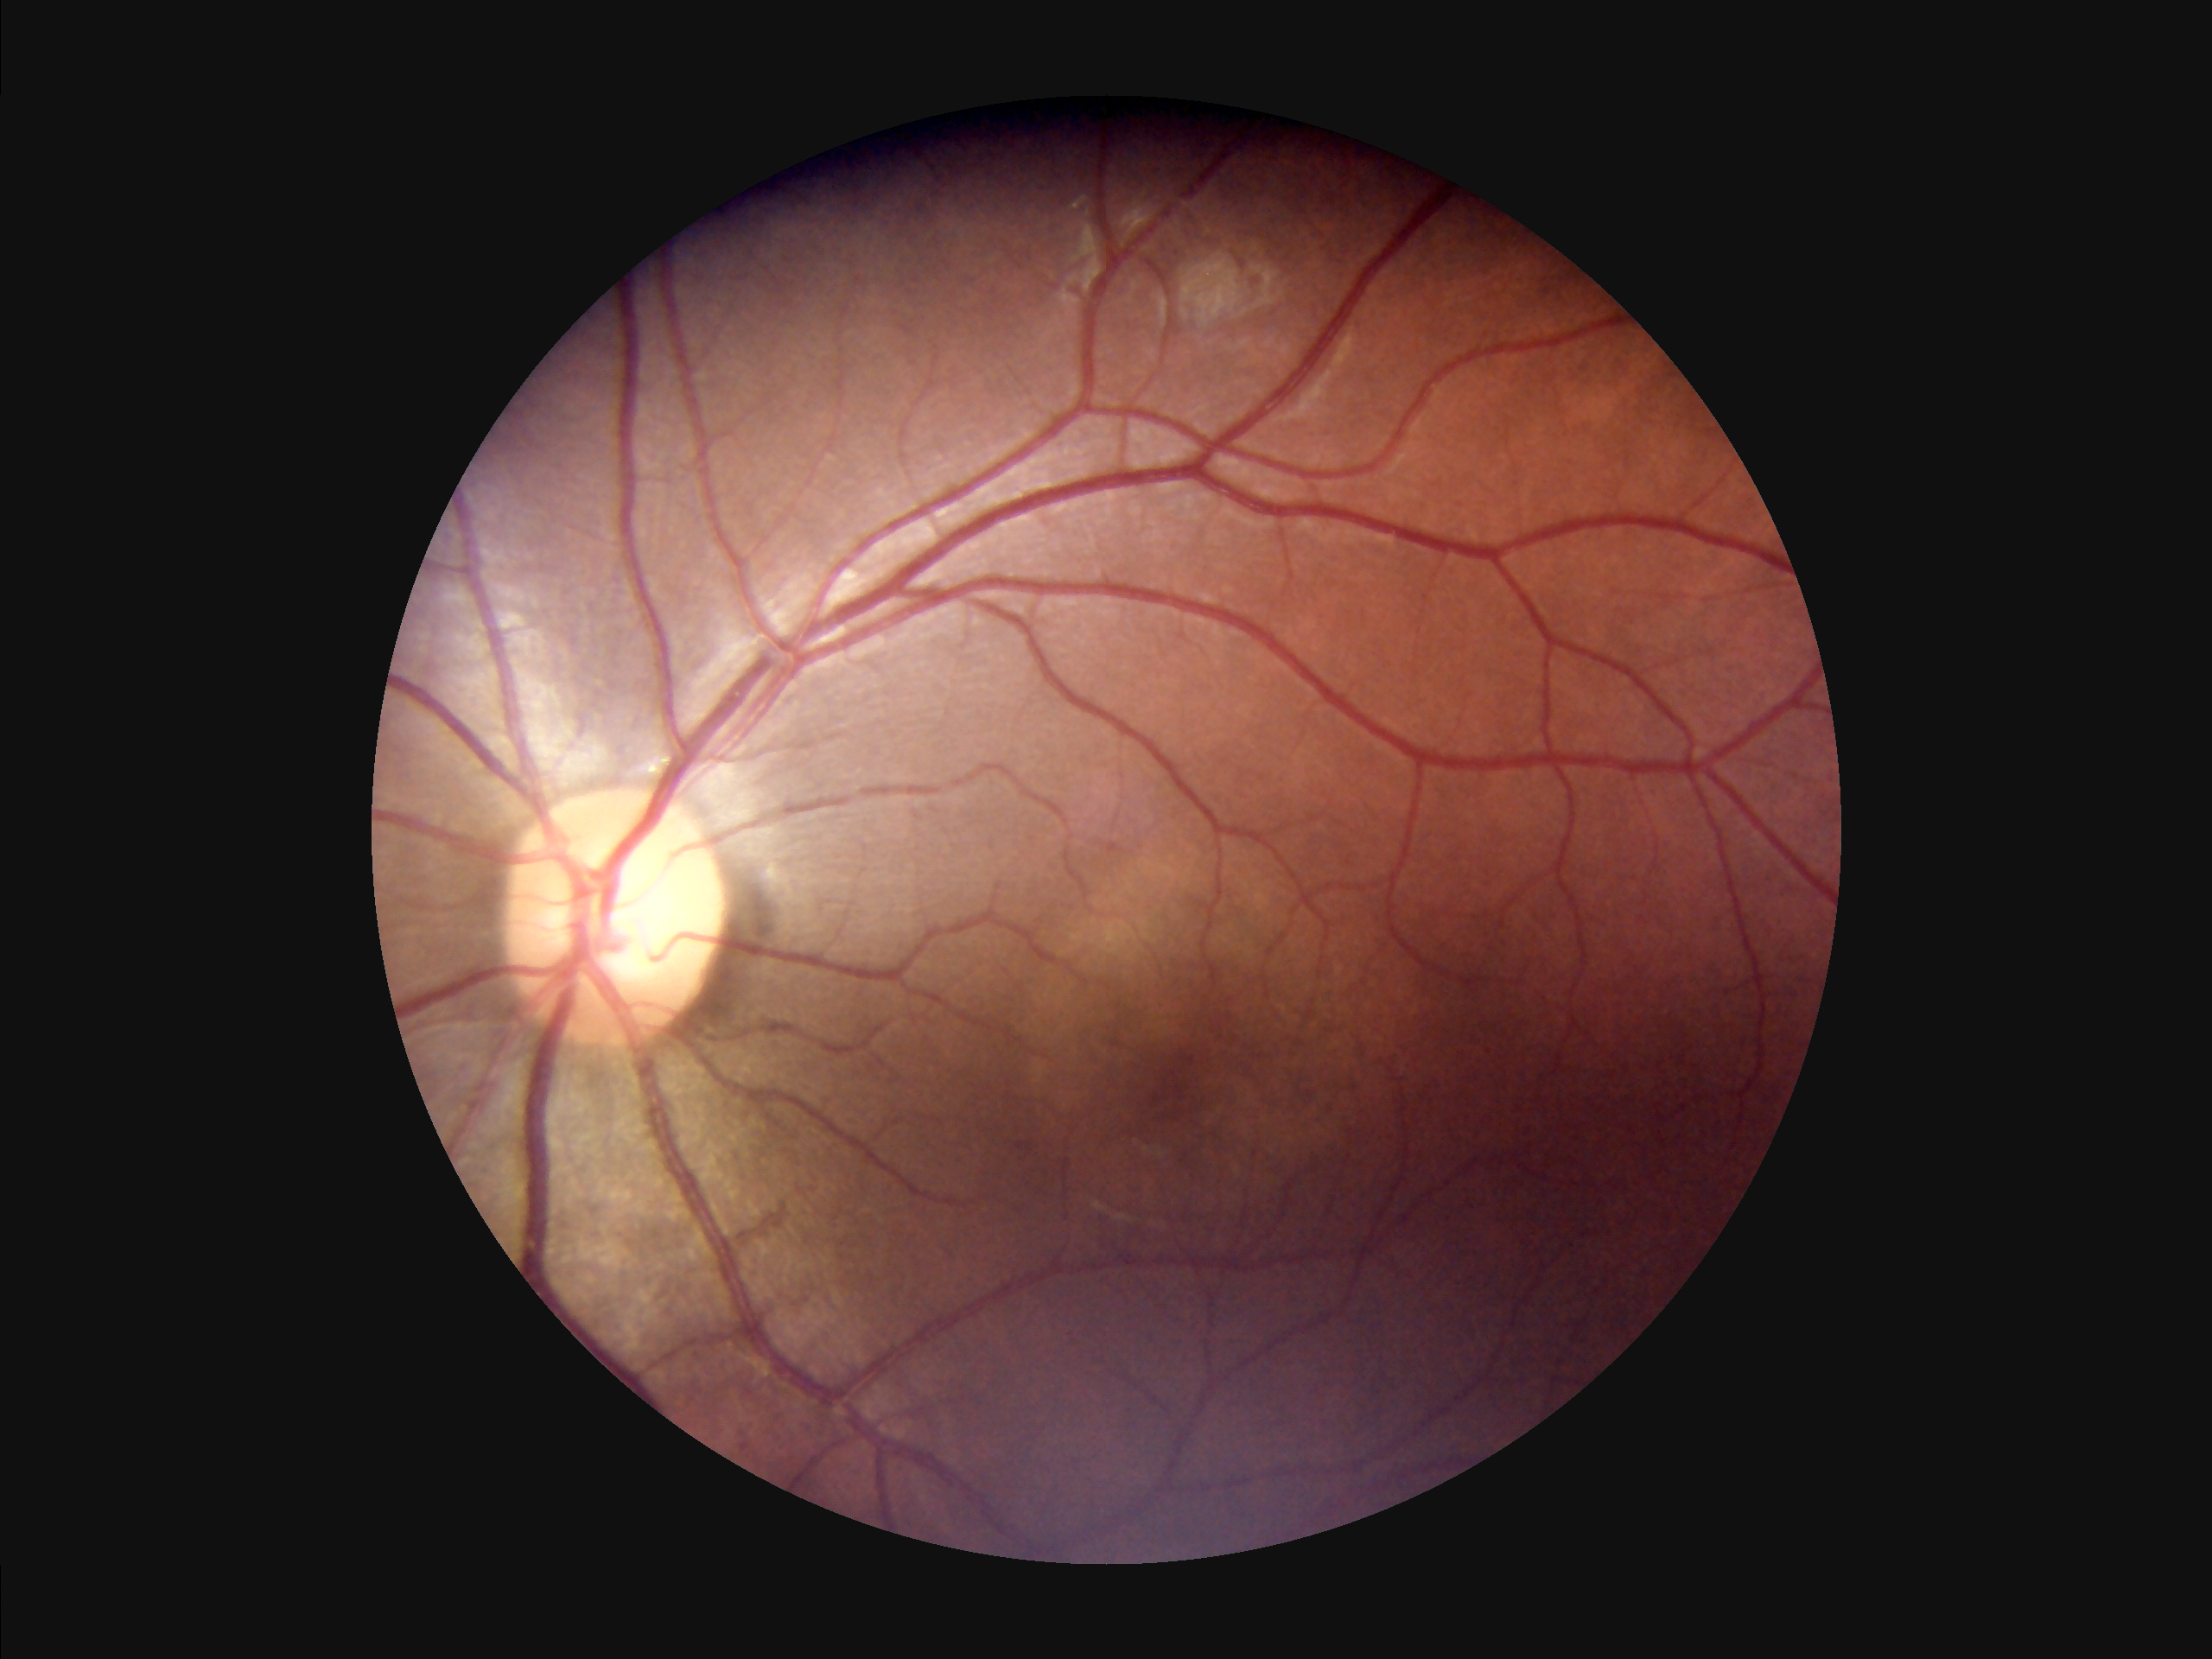

Adequate contrast for distinguishing structures. Overall image quality is good. Poor illumination with uneven exposure.